Fundus photo:
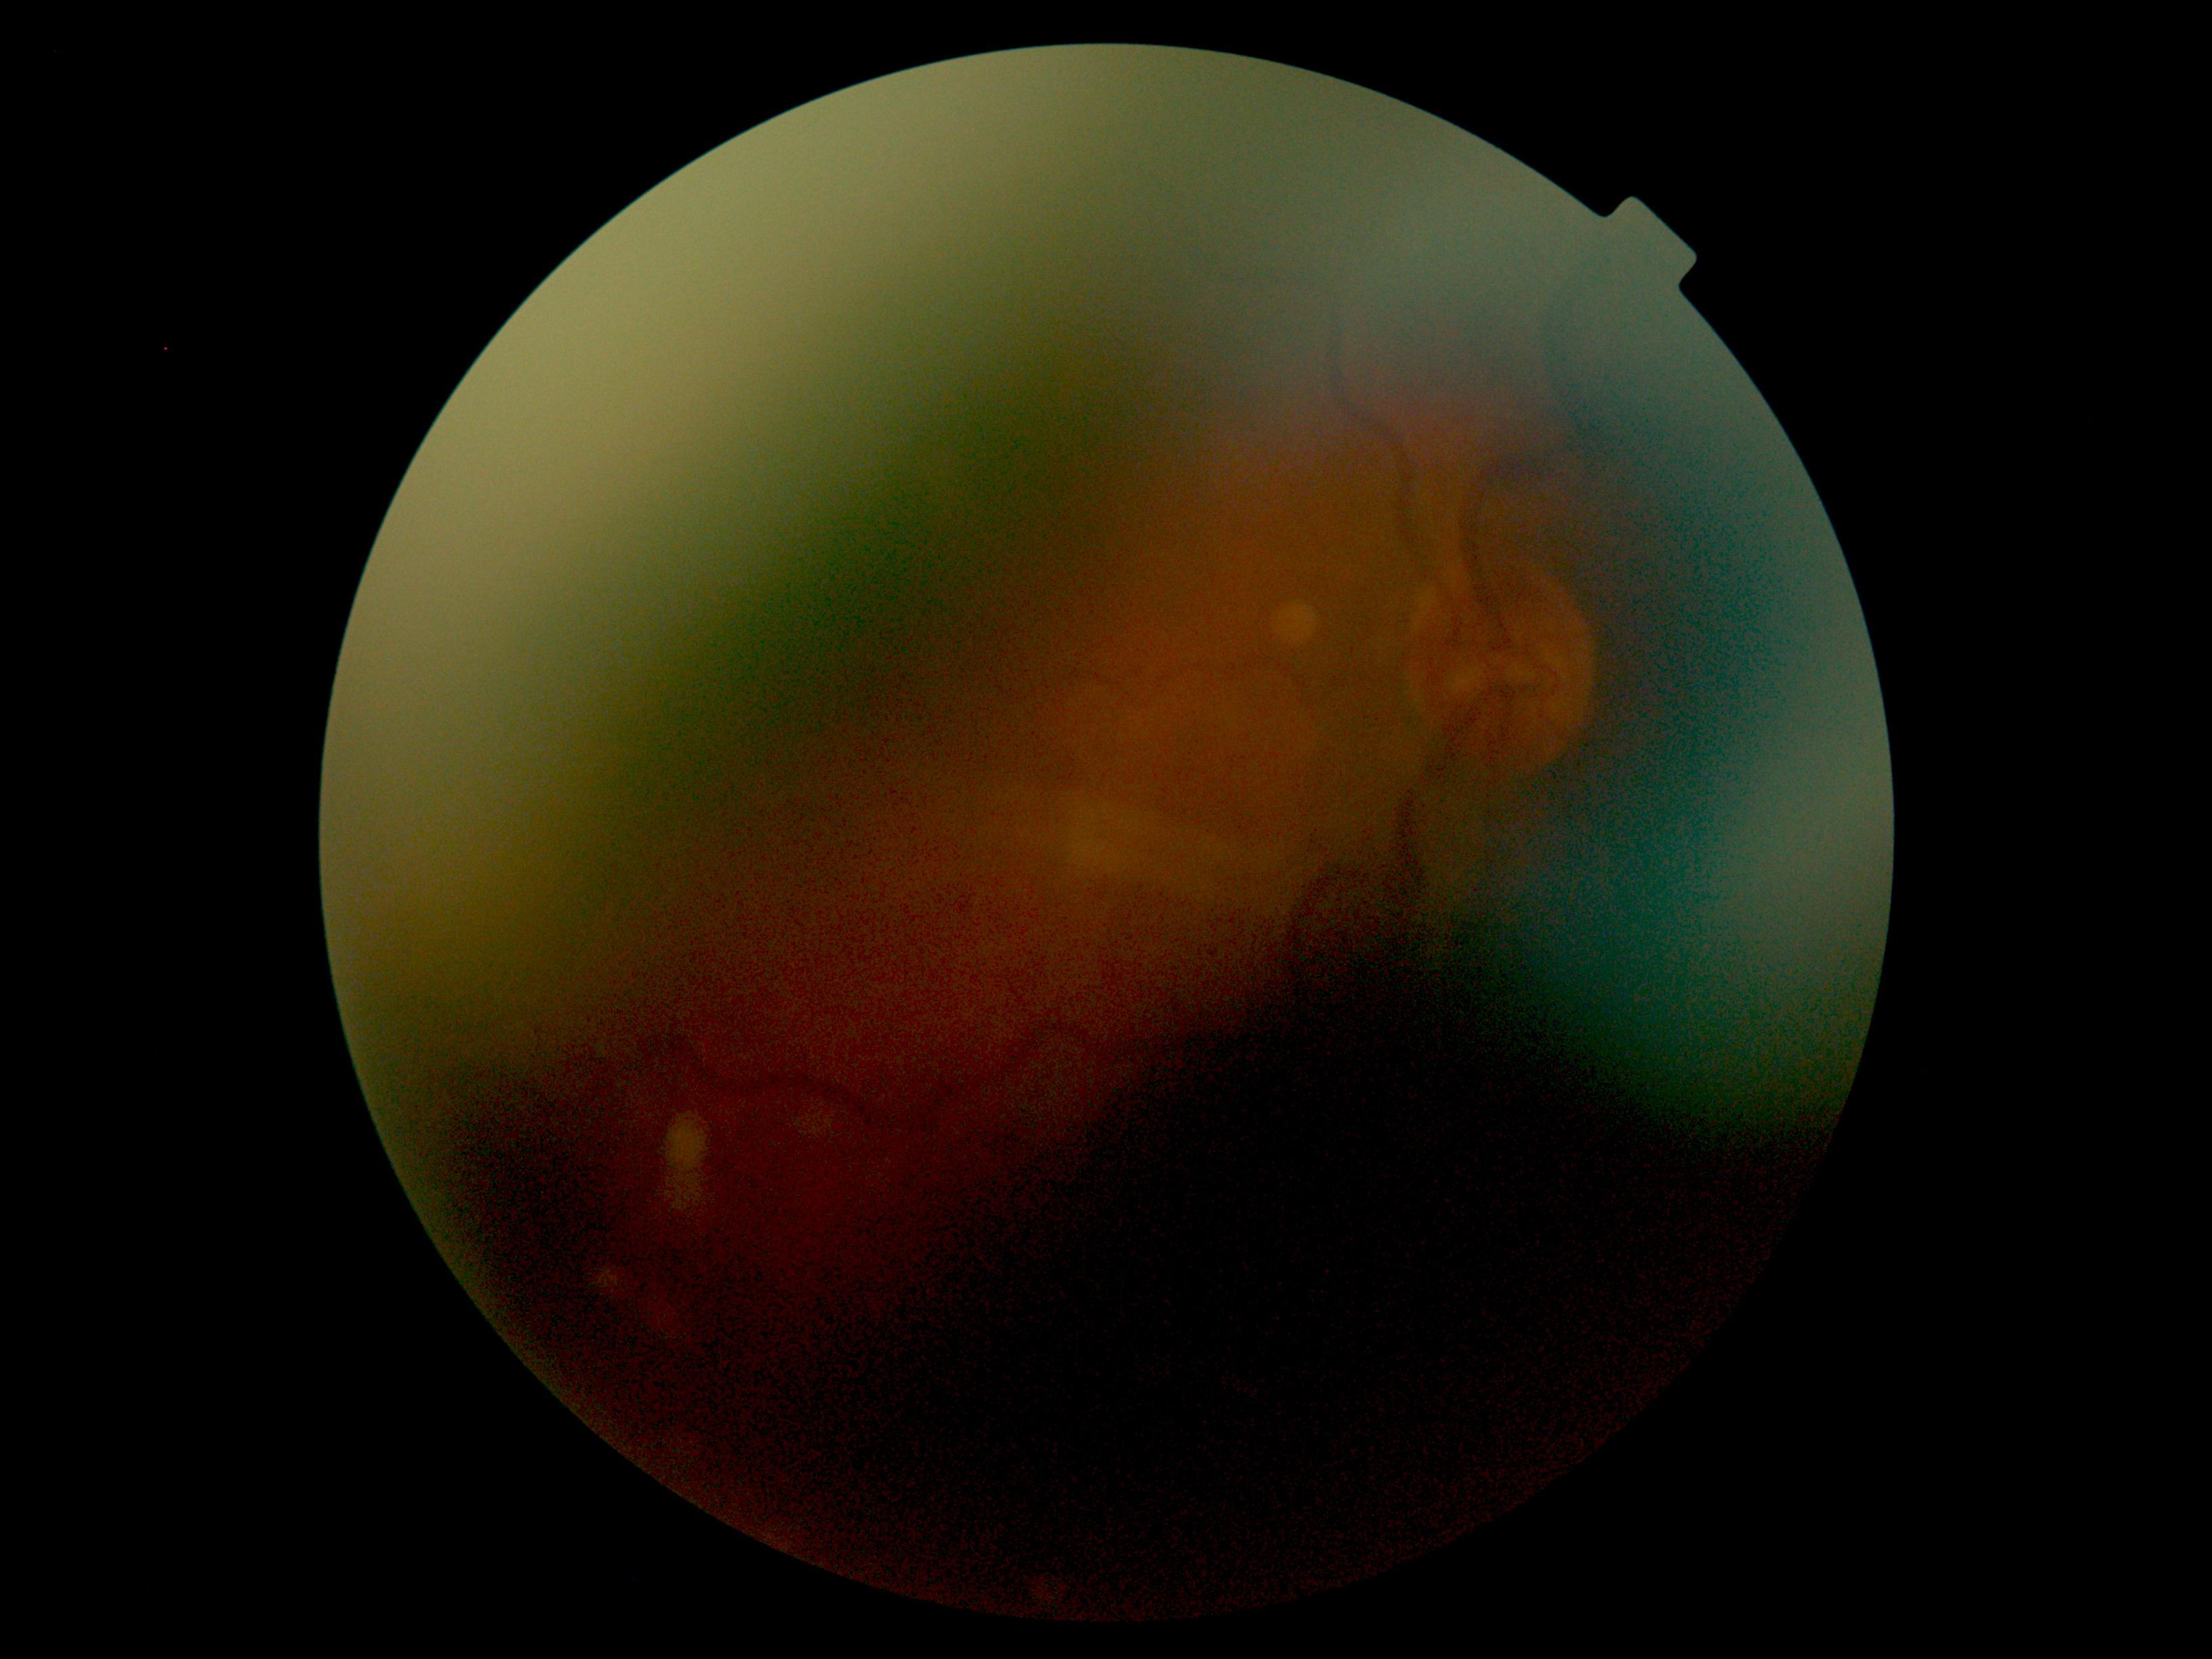 DR stage is ungradable due to poor image quality.